Color fundus image:
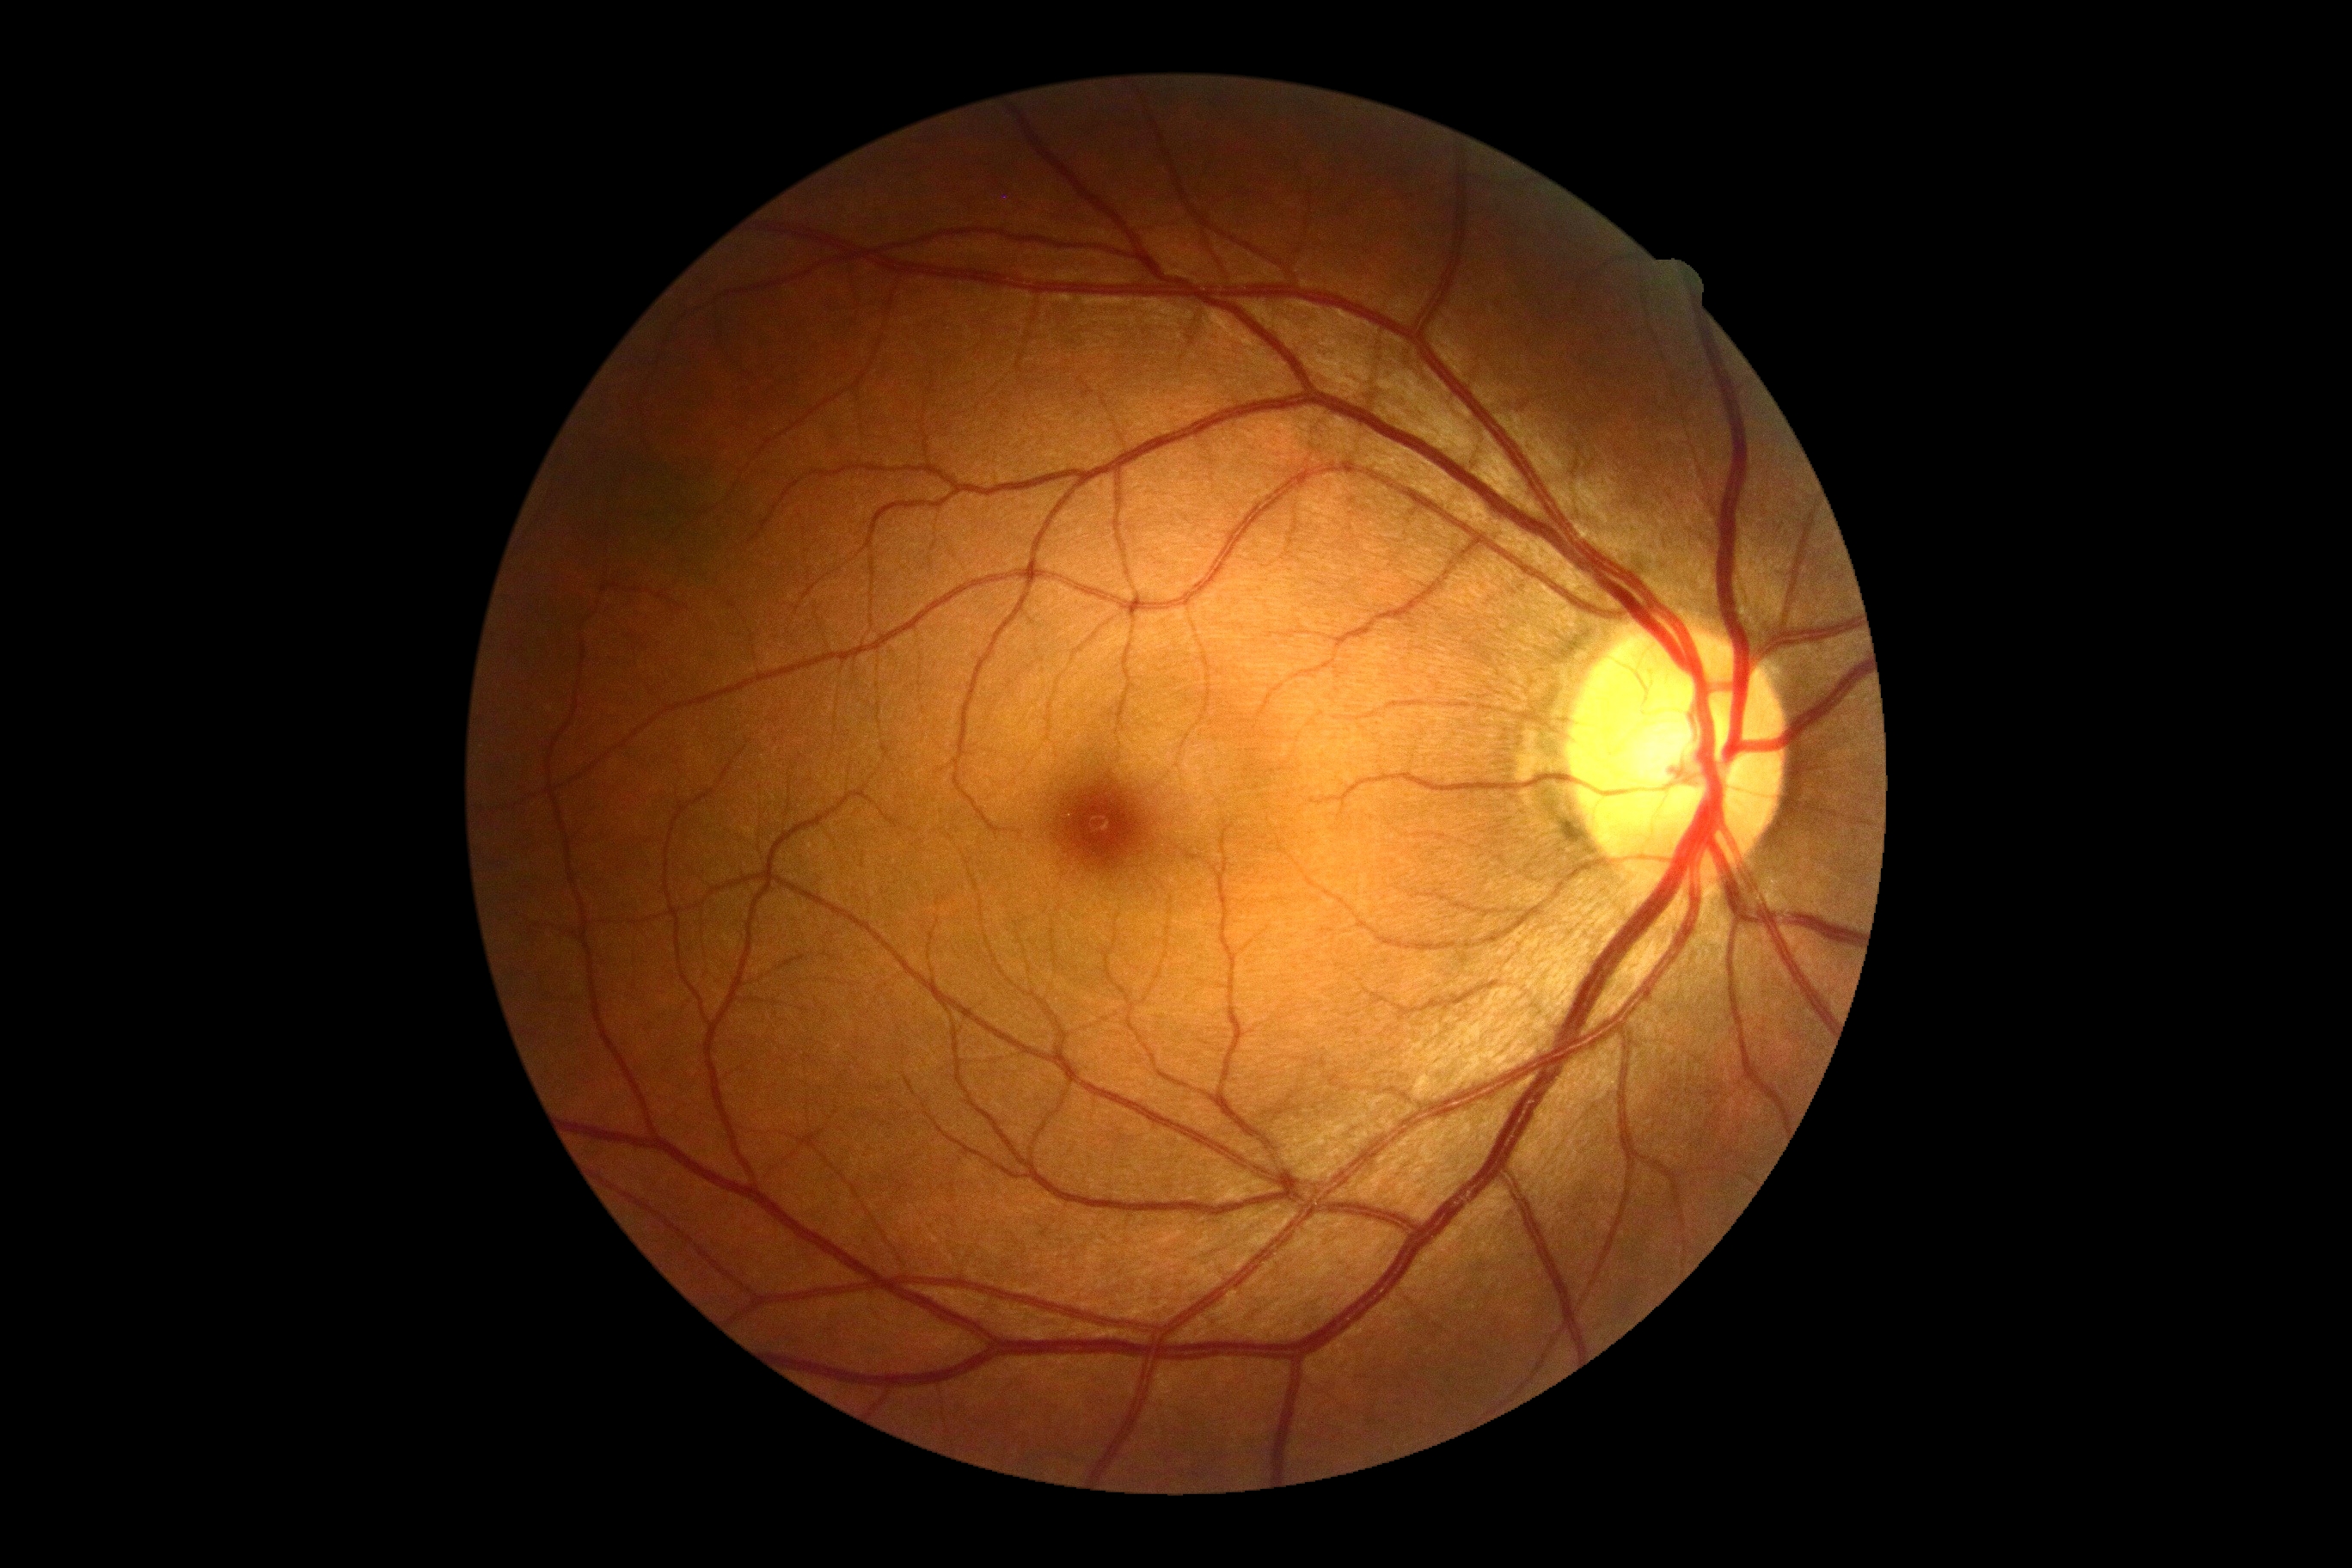 diabetic retinopathy (DR) = grade 0 (no apparent retinopathy).